Camera: NIDEK AFC-230; posterior pole photograph:
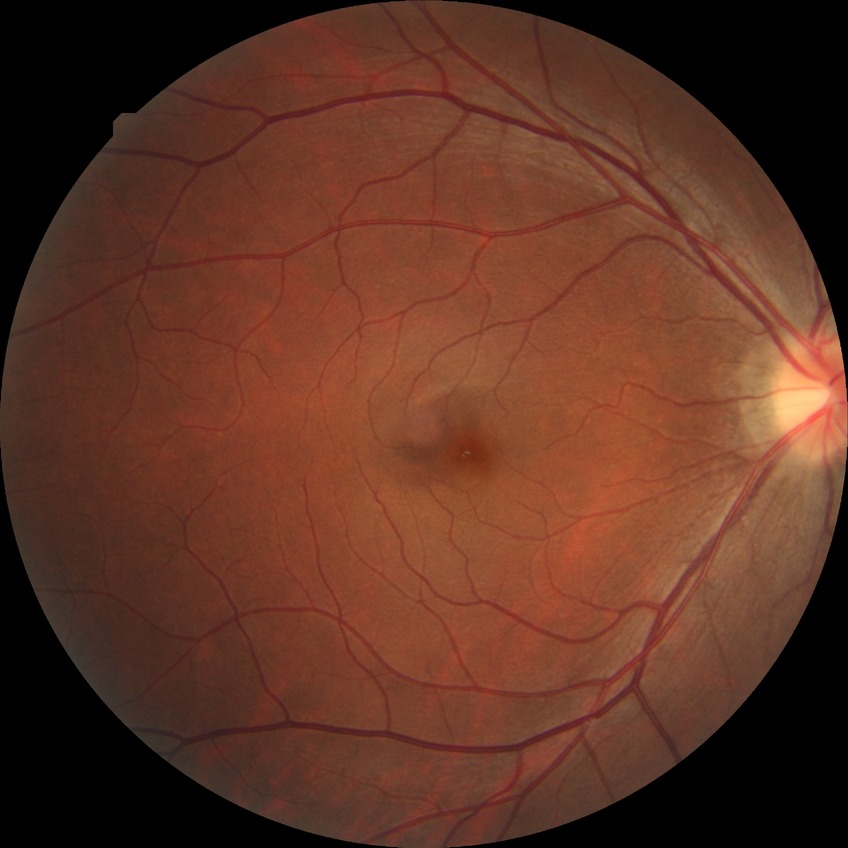

No diabetic retinal disease findings.
Davis stage is NDR.